45 degree fundus photograph · DR severity per modified Davis staging · image size 848x848
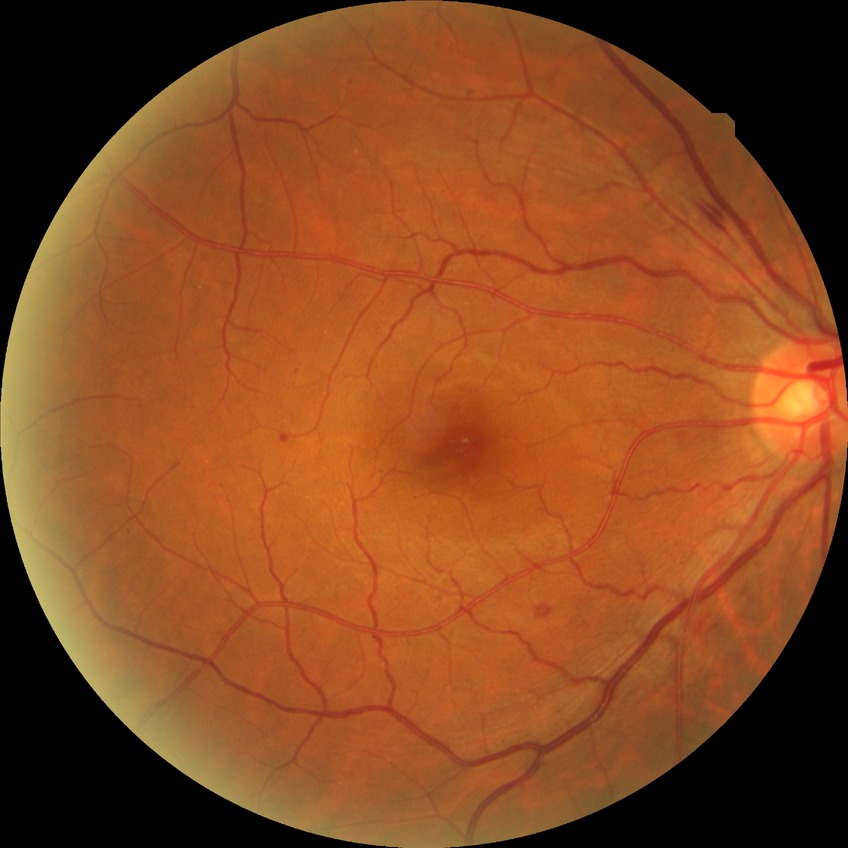 Retinopathy grade is simple diabetic retinopathy.